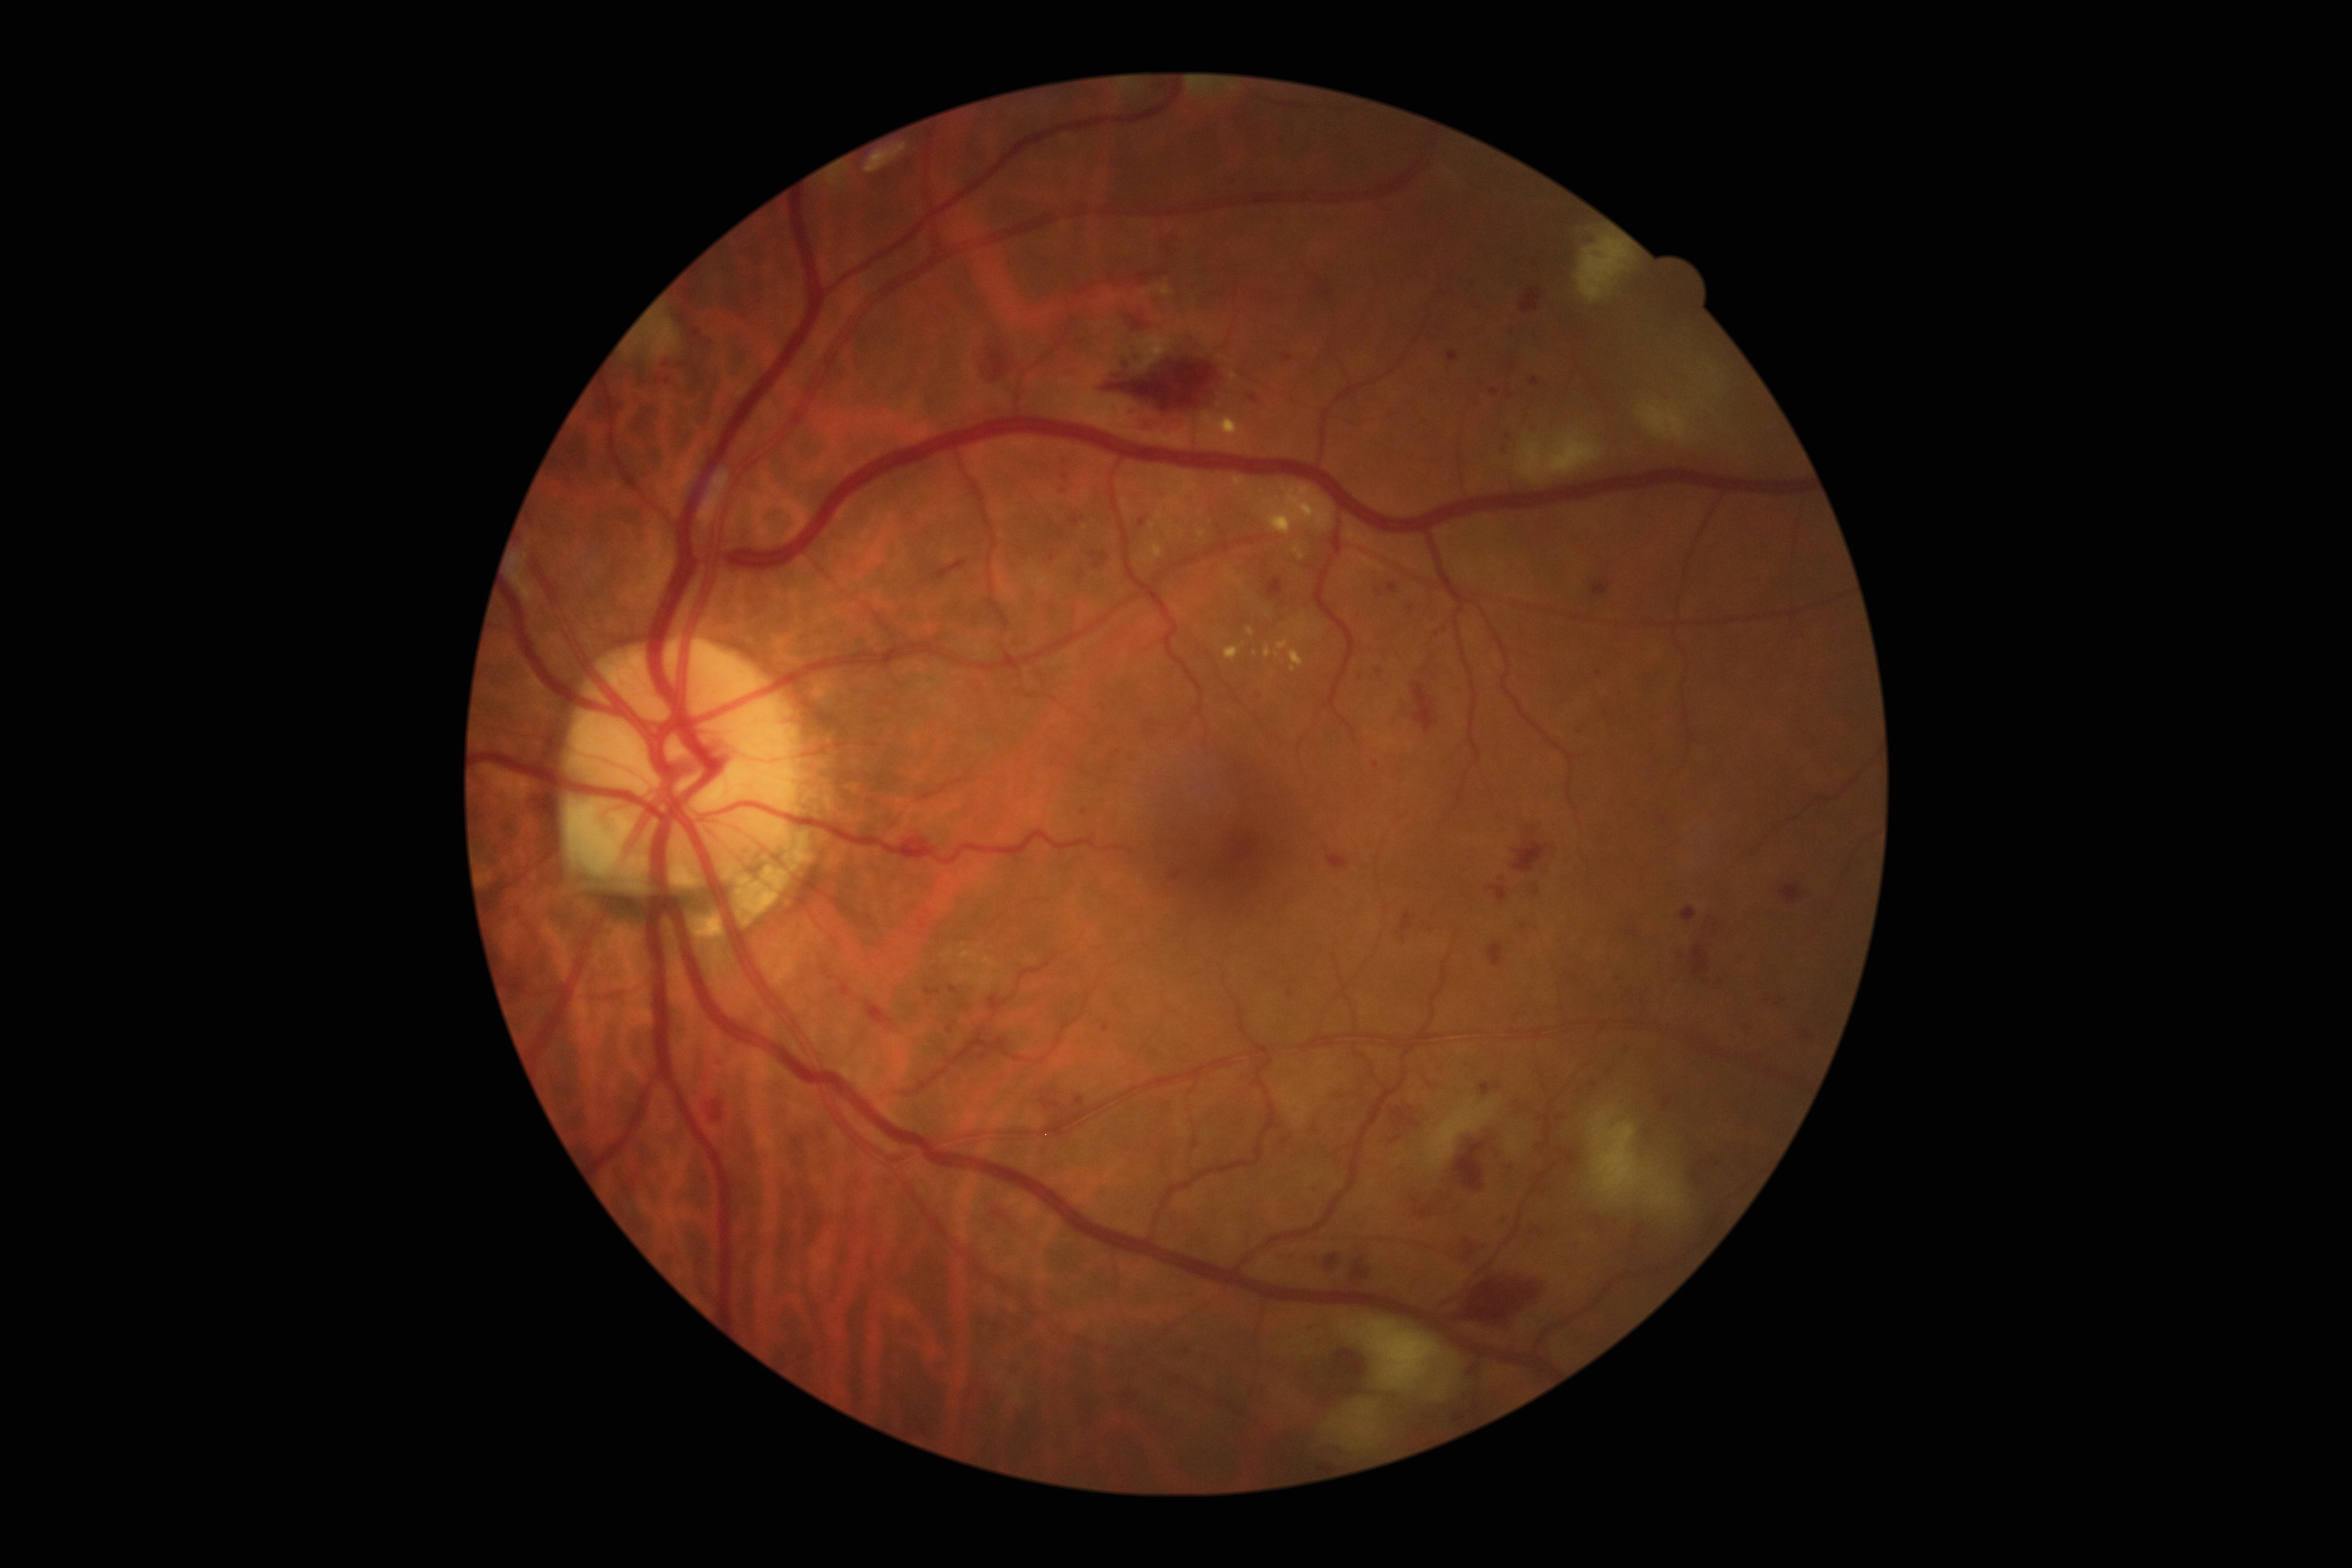 DR = 3/4 — more than 20 intraretinal hemorrhages in each of 4 quadrants, definite venous beading in 2 or more quadrants, or prominent intraretinal microvascular abnormalities in 1 or more quadrants, with no signs of proliferative retinopathy.